Camera: Clarity RetCam 3 (130° FOV). Pediatric wide-field fundus photograph — 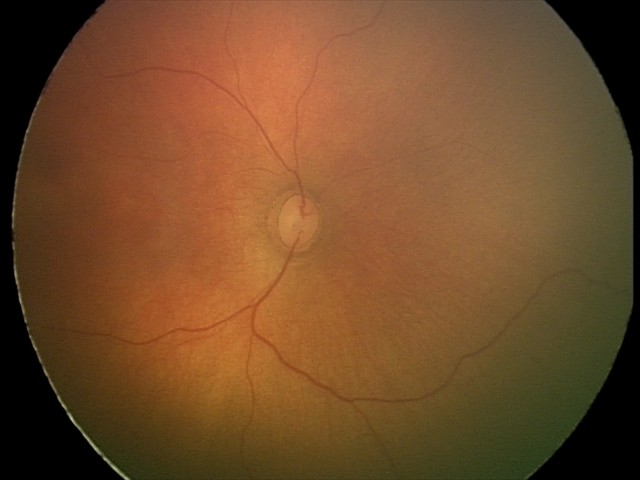

No retinal pathology identified on screening.